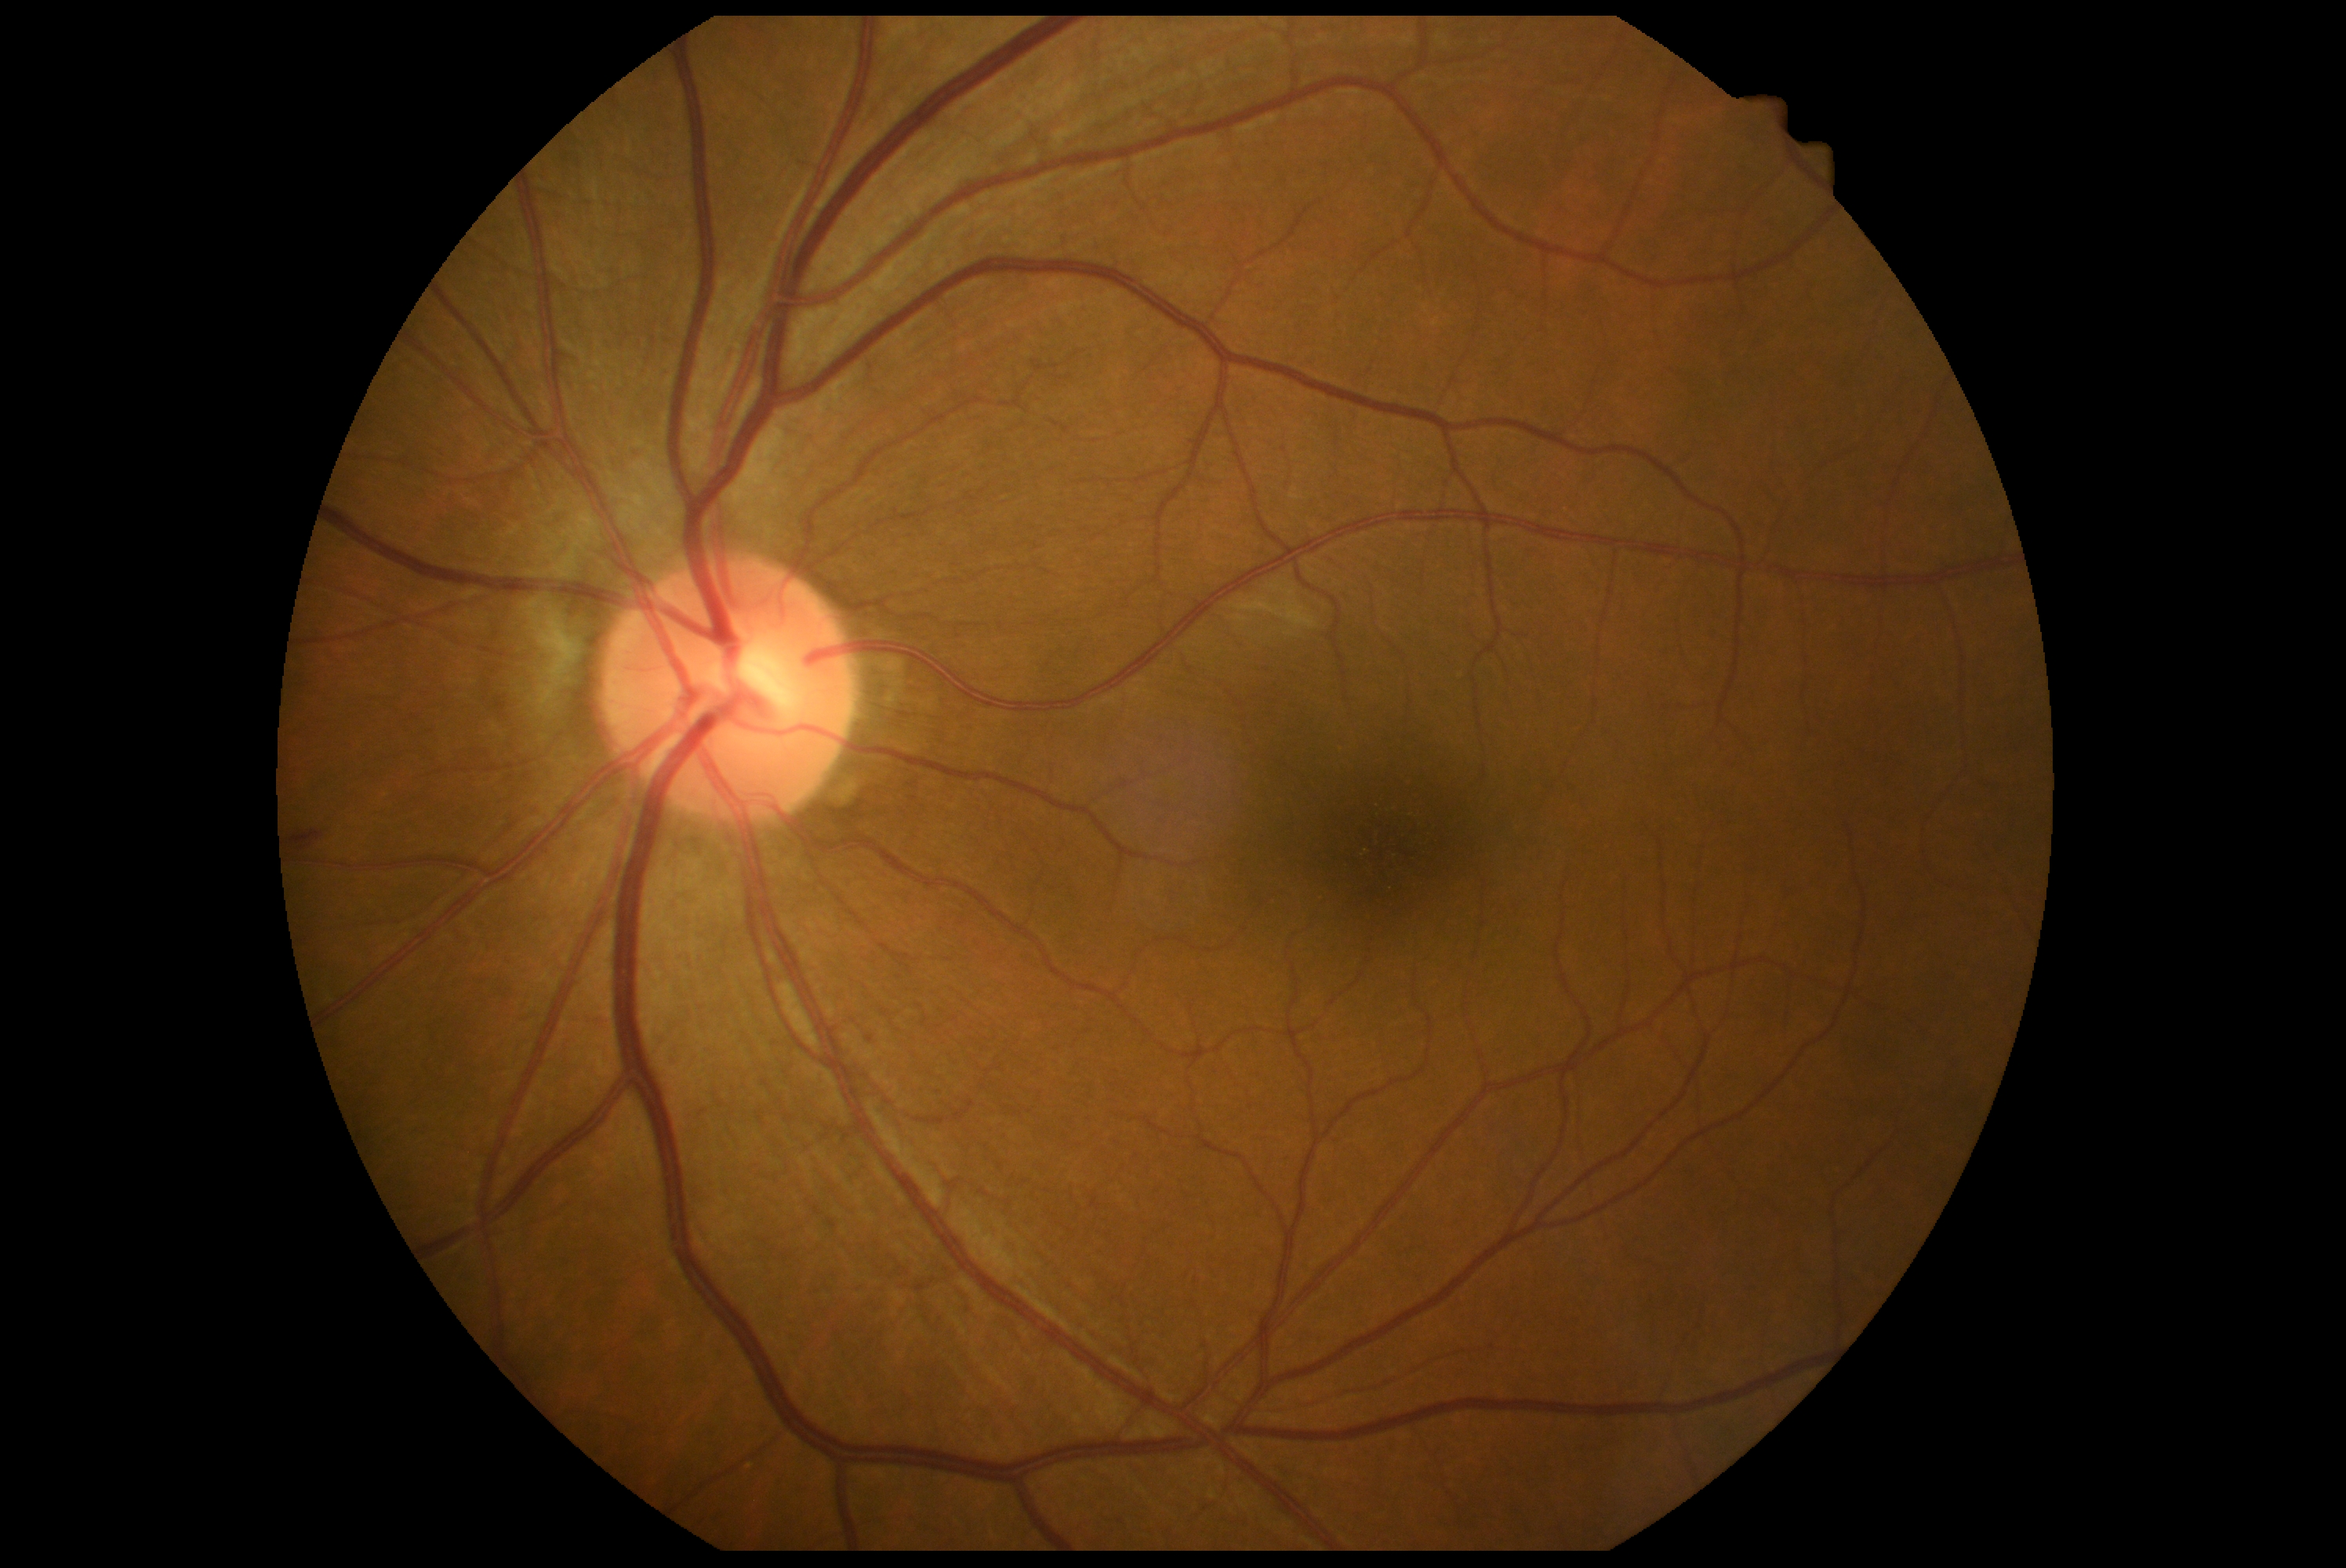 DR stage: grade 2 (moderate NPDR).